Phoenix ICON wide-field infant fundus image. Phoenix ICON, 100° FOV: 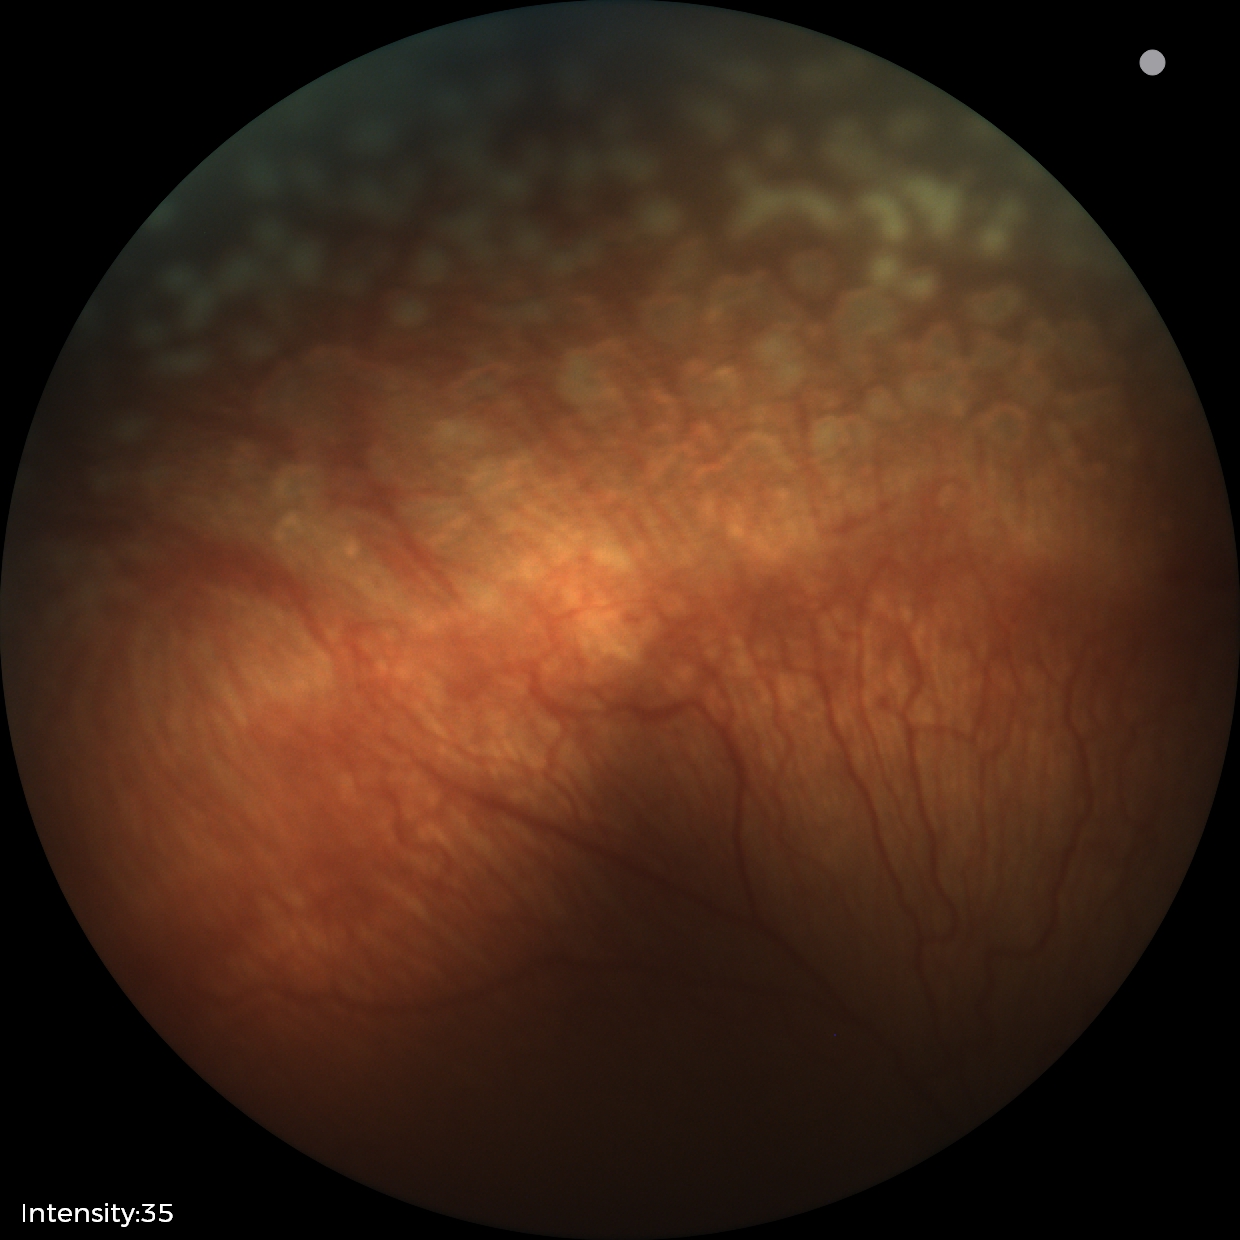

Plus disease present. Screening series with retinopathy of prematurity (ROP) stage 2.